848x848px, 45° FOV, without pupil dilation:
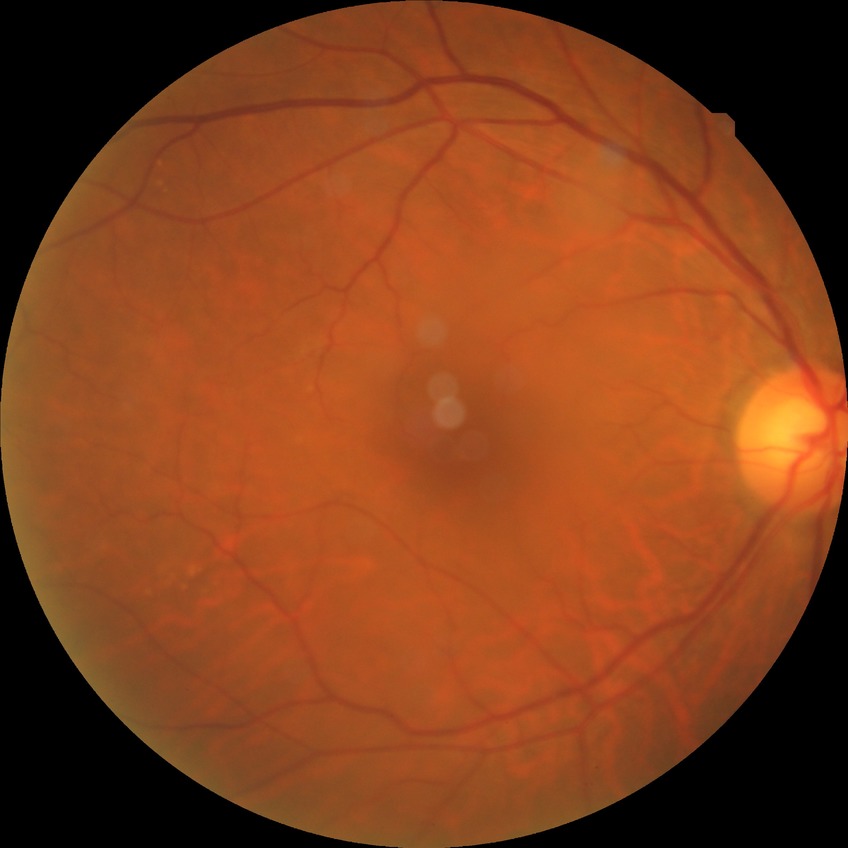
diabetic retinopathy (DR) = NDR (no diabetic retinopathy)